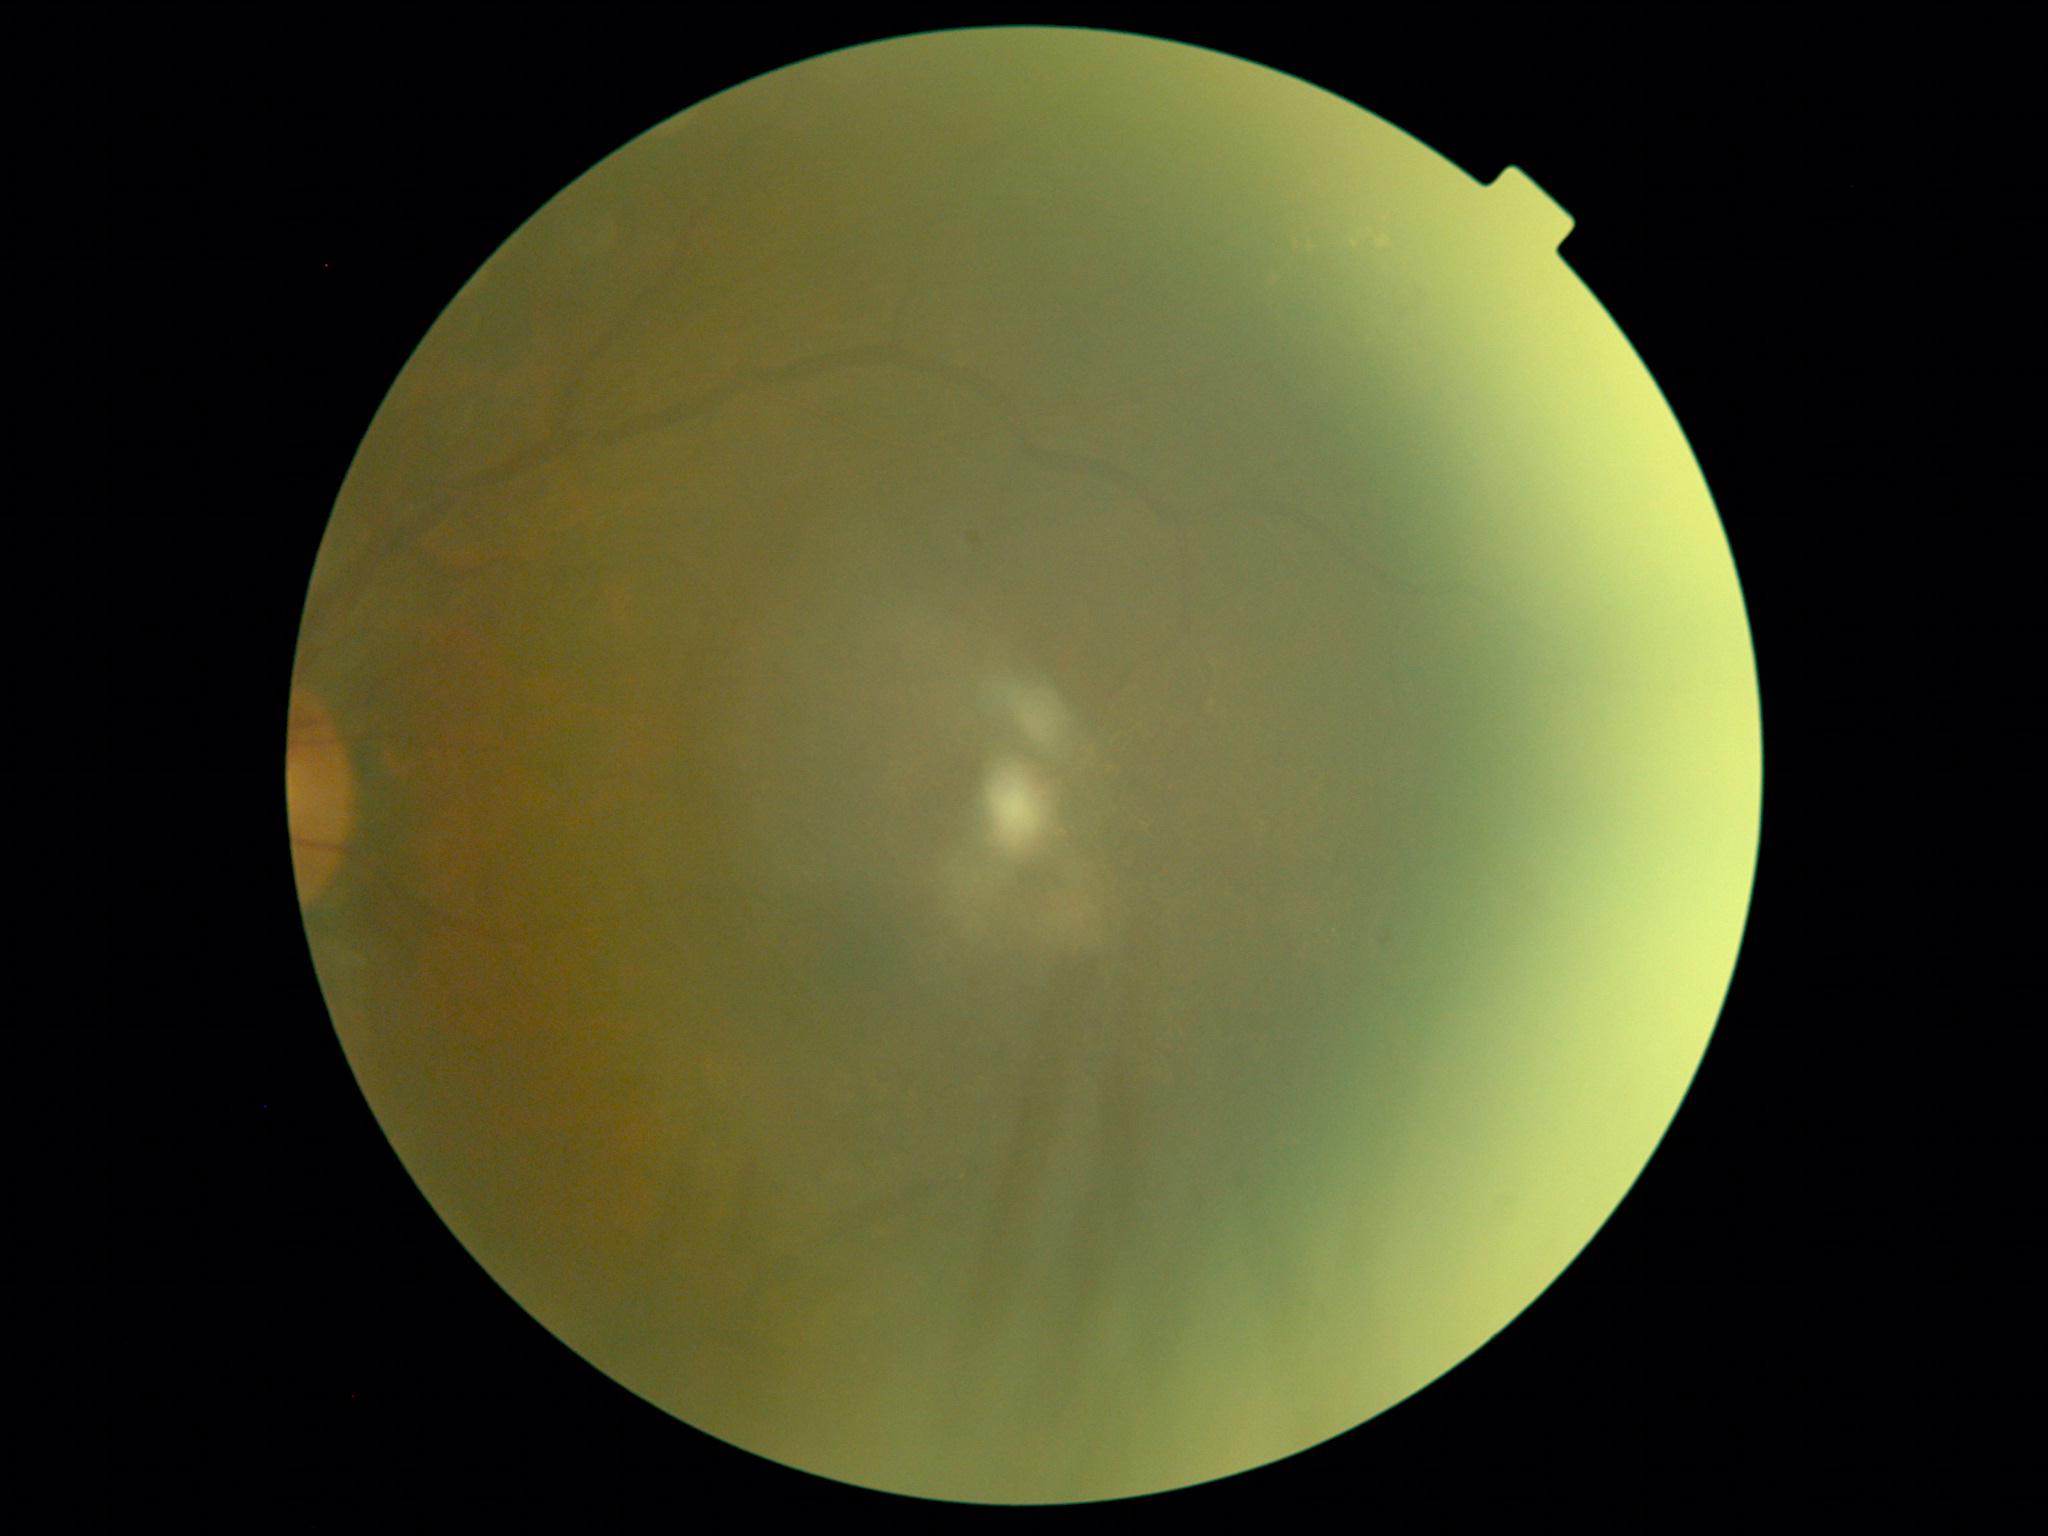

{
  "dr_grade": "2/4",
  "dr_category": "non-proliferative diabetic retinopathy"
}